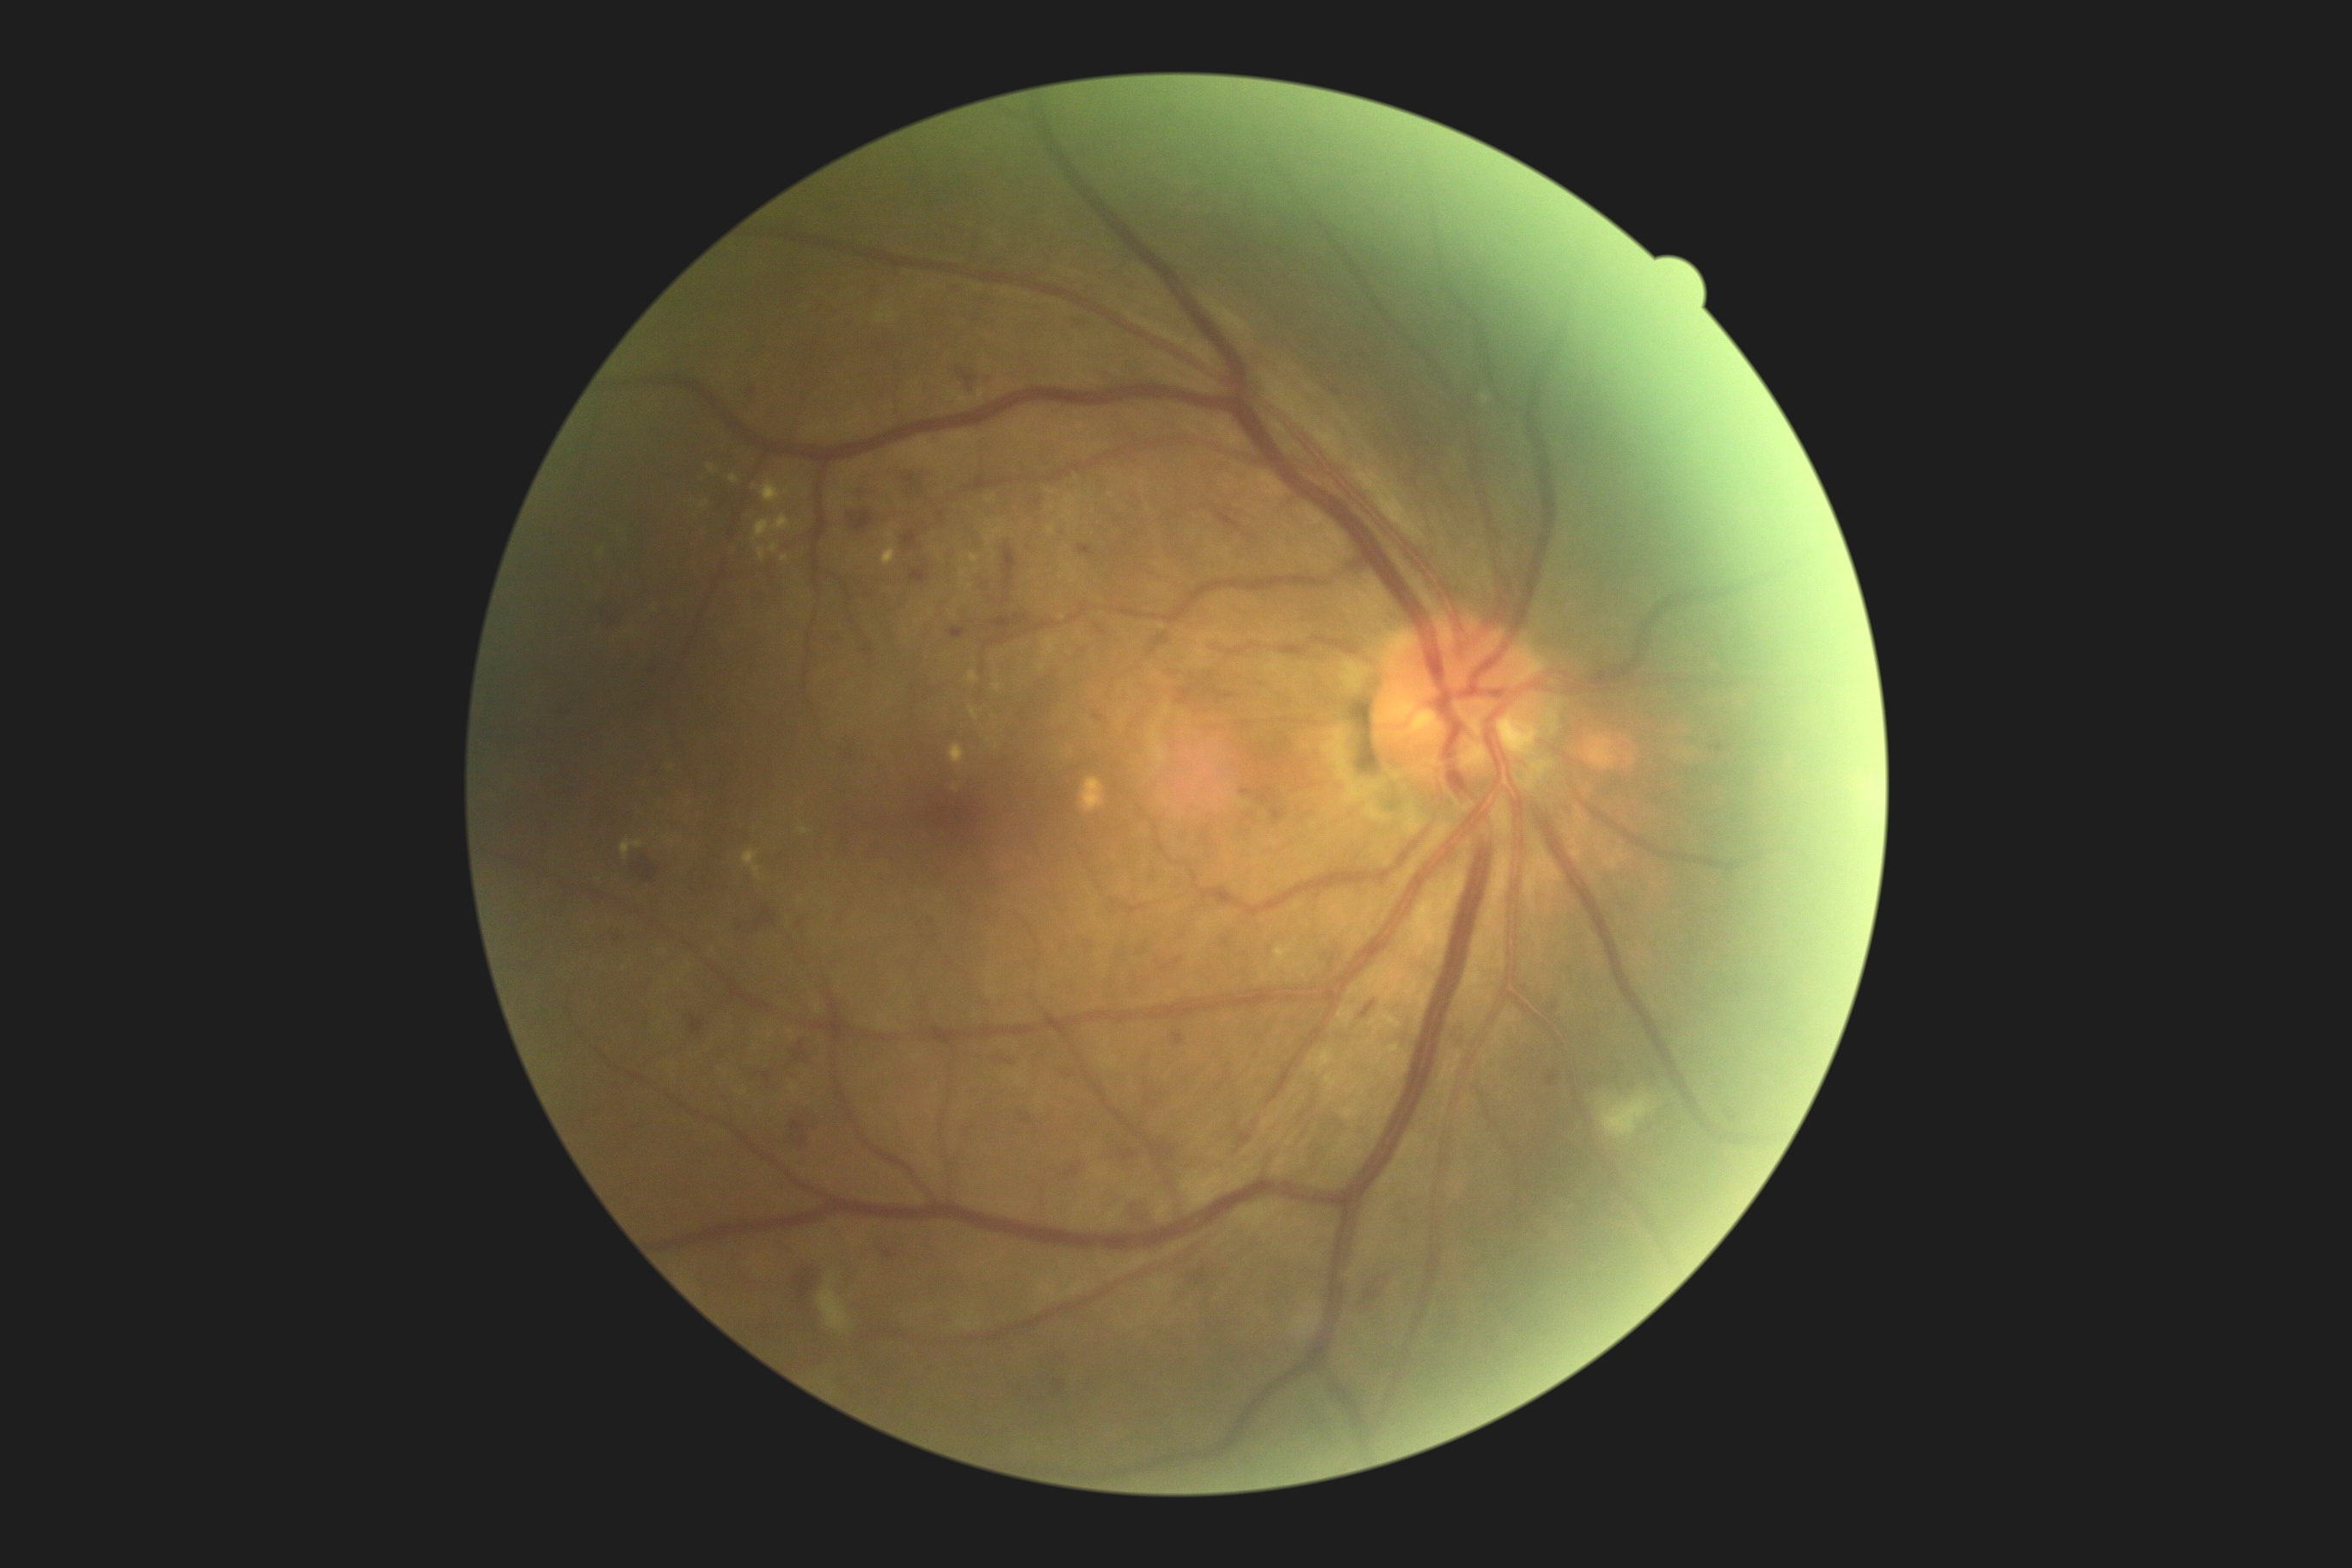 DR stage is 2
Representative lesions:
MAs (subset): x1=1005, y1=596, x2=1017, y2=609 | x1=1093, y1=713, x2=1105, y2=721 | x1=826, y1=634, x2=848, y2=647 | x1=1271, y1=809, x2=1282, y2=821 | x1=1098, y1=627, x2=1106, y2=634 | x1=558, y1=711, x2=565, y2=721 | x1=933, y1=436, x2=940, y2=444 | x1=883, y1=1249, x2=895, y2=1259 | x1=793, y1=1043, x2=811, y2=1062 | x1=1172, y1=1032, x2=1184, y2=1044 | x1=1240, y1=788, x2=1253, y2=795 | x1=979, y1=579, x2=988, y2=587
Smaller MAs around [942, 515] | [562, 913] | [801, 924] | [1024, 618] | [1225, 943] | [989, 599] | [1251, 816]
HEs (subset): x1=690, y1=1015, x2=704, y2=1034 | x1=957, y1=365, x2=996, y2=393 | x1=903, y1=530, x2=917, y2=546 | x1=948, y1=627, x2=965, y2=639 | x1=1003, y1=546, x2=1017, y2=587 | x1=1364, y1=1263, x2=1400, y2=1306 | x1=787, y1=1112, x2=821, y2=1149 | x1=991, y1=616, x2=1012, y2=634 | x1=1179, y1=1259, x2=1218, y2=1289 | x1=898, y1=463, x2=929, y2=494 | x1=1177, y1=685, x2=1199, y2=706
EXs (subset): x1=881, y1=546, x2=897, y2=567 | x1=1344, y1=1103, x2=1363, y2=1118 | x1=960, y1=570, x2=967, y2=580 | x1=1062, y1=496, x2=1075, y2=522 | x1=816, y1=1005, x2=821, y2=1014 | x1=763, y1=482, x2=783, y2=505 | x1=790, y1=1082, x2=800, y2=1094 | x1=771, y1=544, x2=778, y2=553 | x1=989, y1=527, x2=1005, y2=537 | x1=1048, y1=527, x2=1057, y2=536 | x1=752, y1=515, x2=792, y2=542 | x1=986, y1=496, x2=995, y2=503 | x1=1308, y1=1050, x2=1335, y2=1072 | x1=1044, y1=489, x2=1057, y2=494
Smaller EXs around [977, 571] | [602, 551] | [1052, 508] | [930, 612]
SEs: x1=1596, y1=1094, x2=1657, y2=1139 | x1=818, y1=1275, x2=852, y2=1332 | x1=1481, y1=395, x2=1491, y2=405